Nonmydriatic: 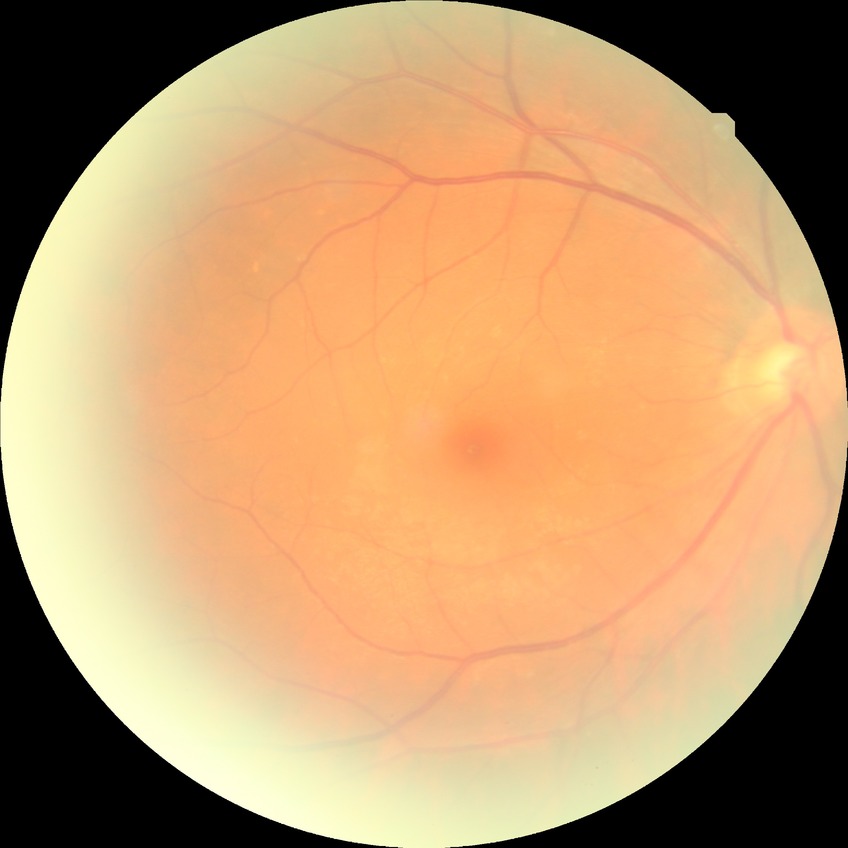

{
  "davis_grade": "no diabetic retinopathy"
}